Image size 2048x1536 · color fundus photograph · Forus 3Nethra Classic fundus camera: 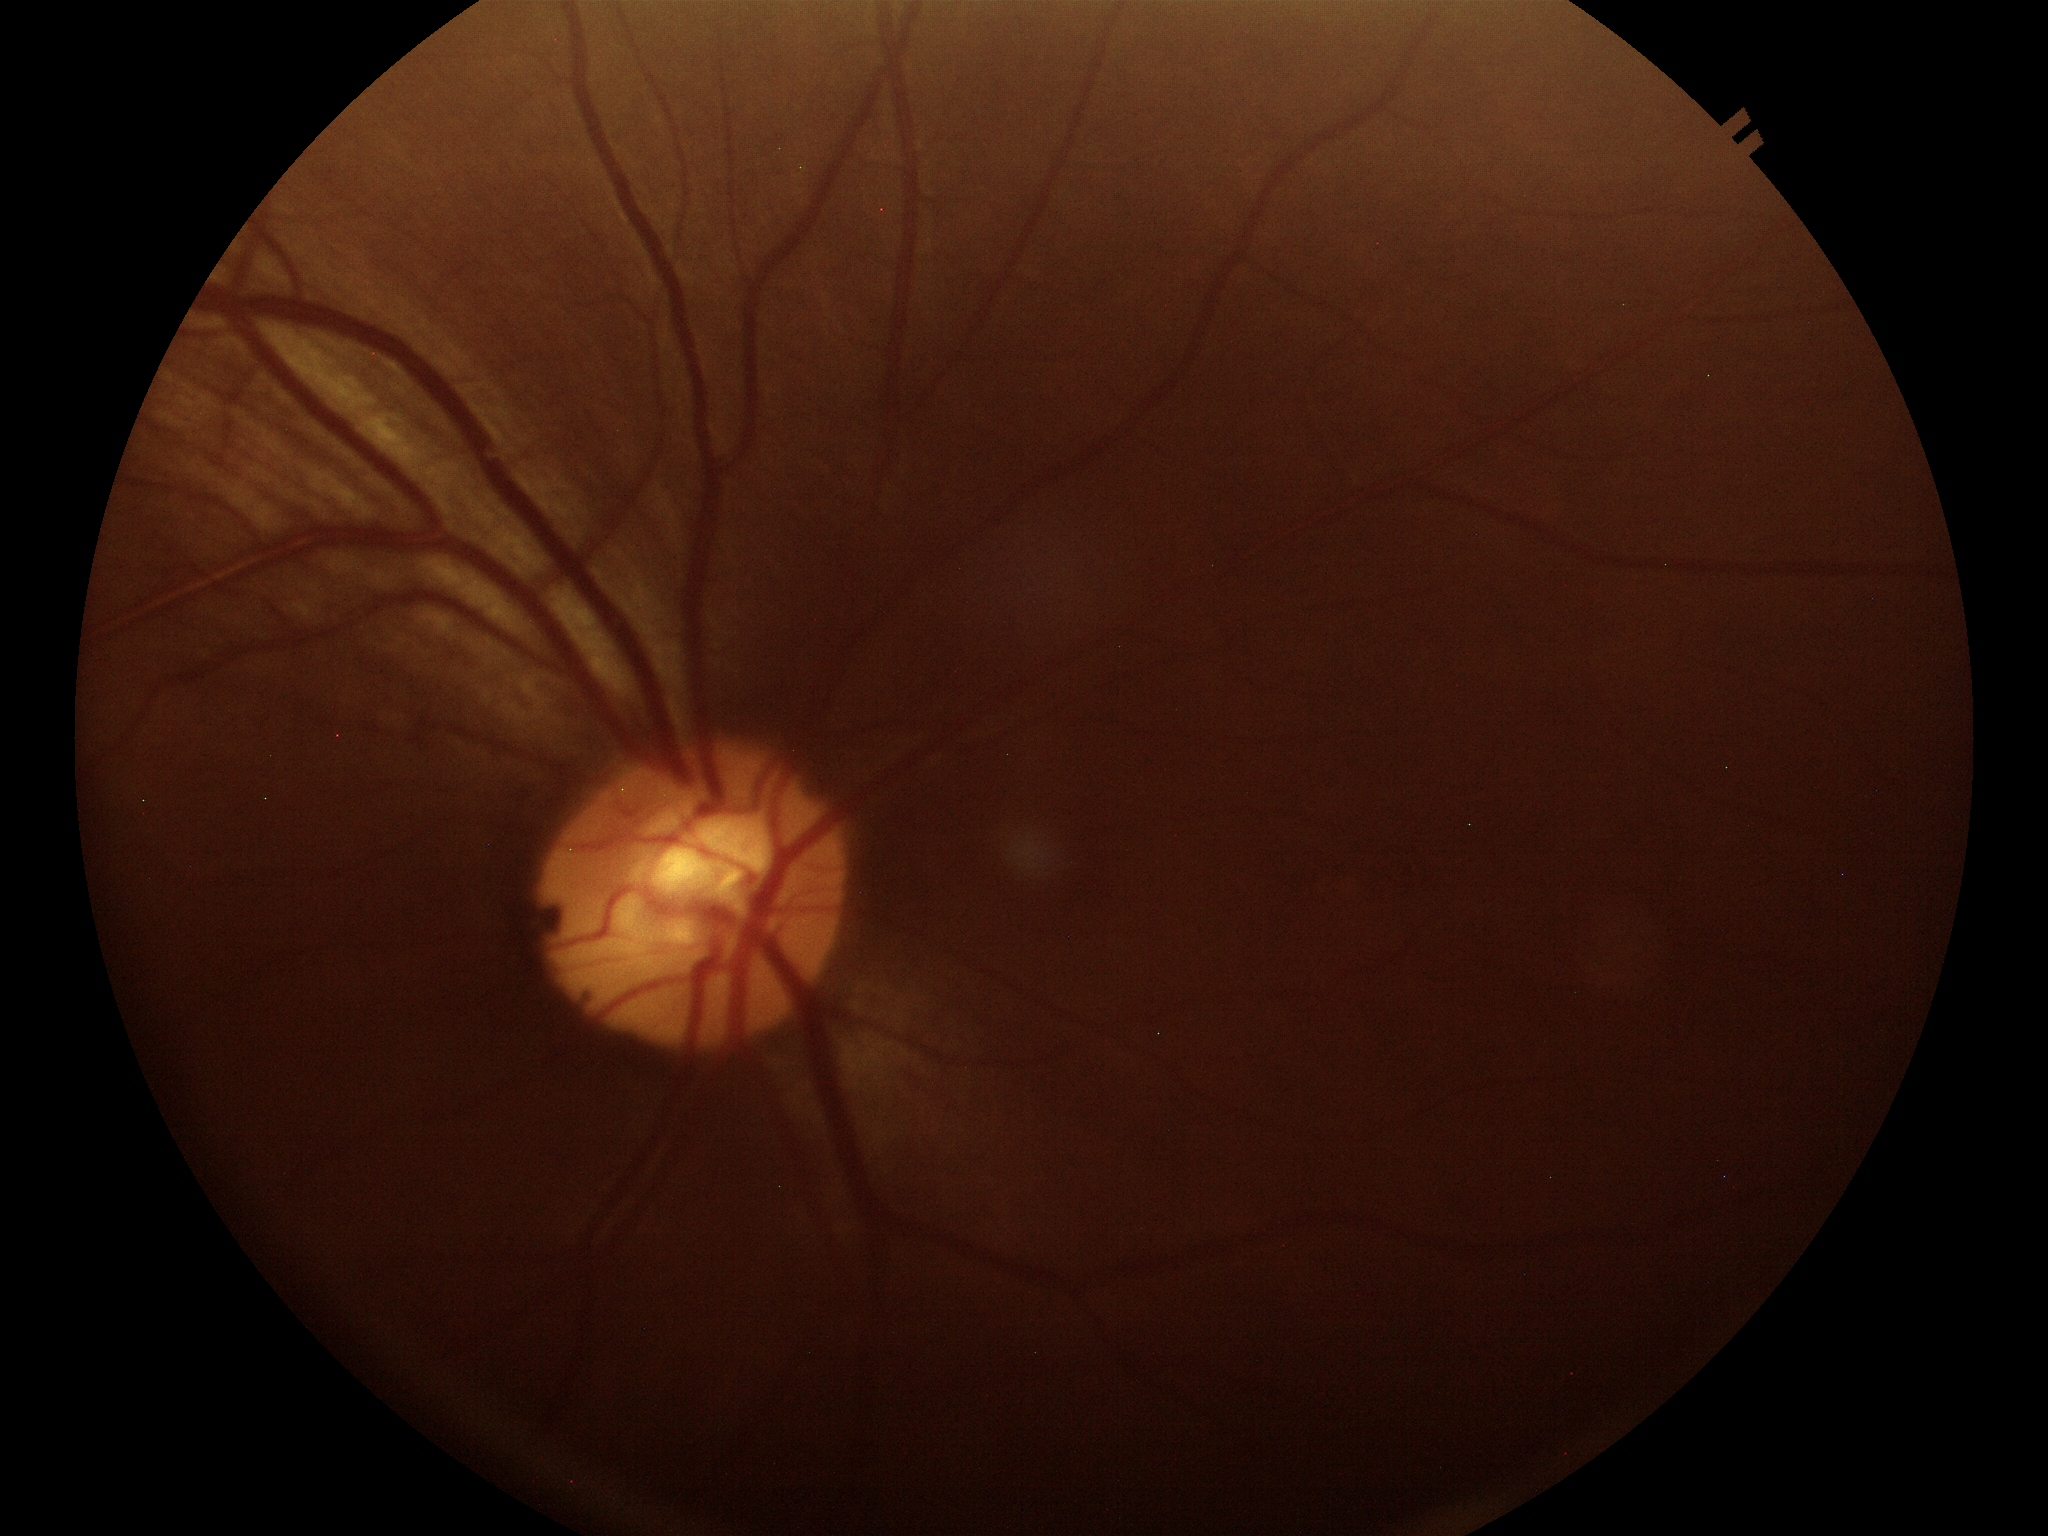
Findings:
– vertical cup-disc ratio — 0.57
– Glaucoma screening impression — not suspect
– horizontal C/D ratio — 0.54